Acquired with a Remidio smartphone fundus camera:
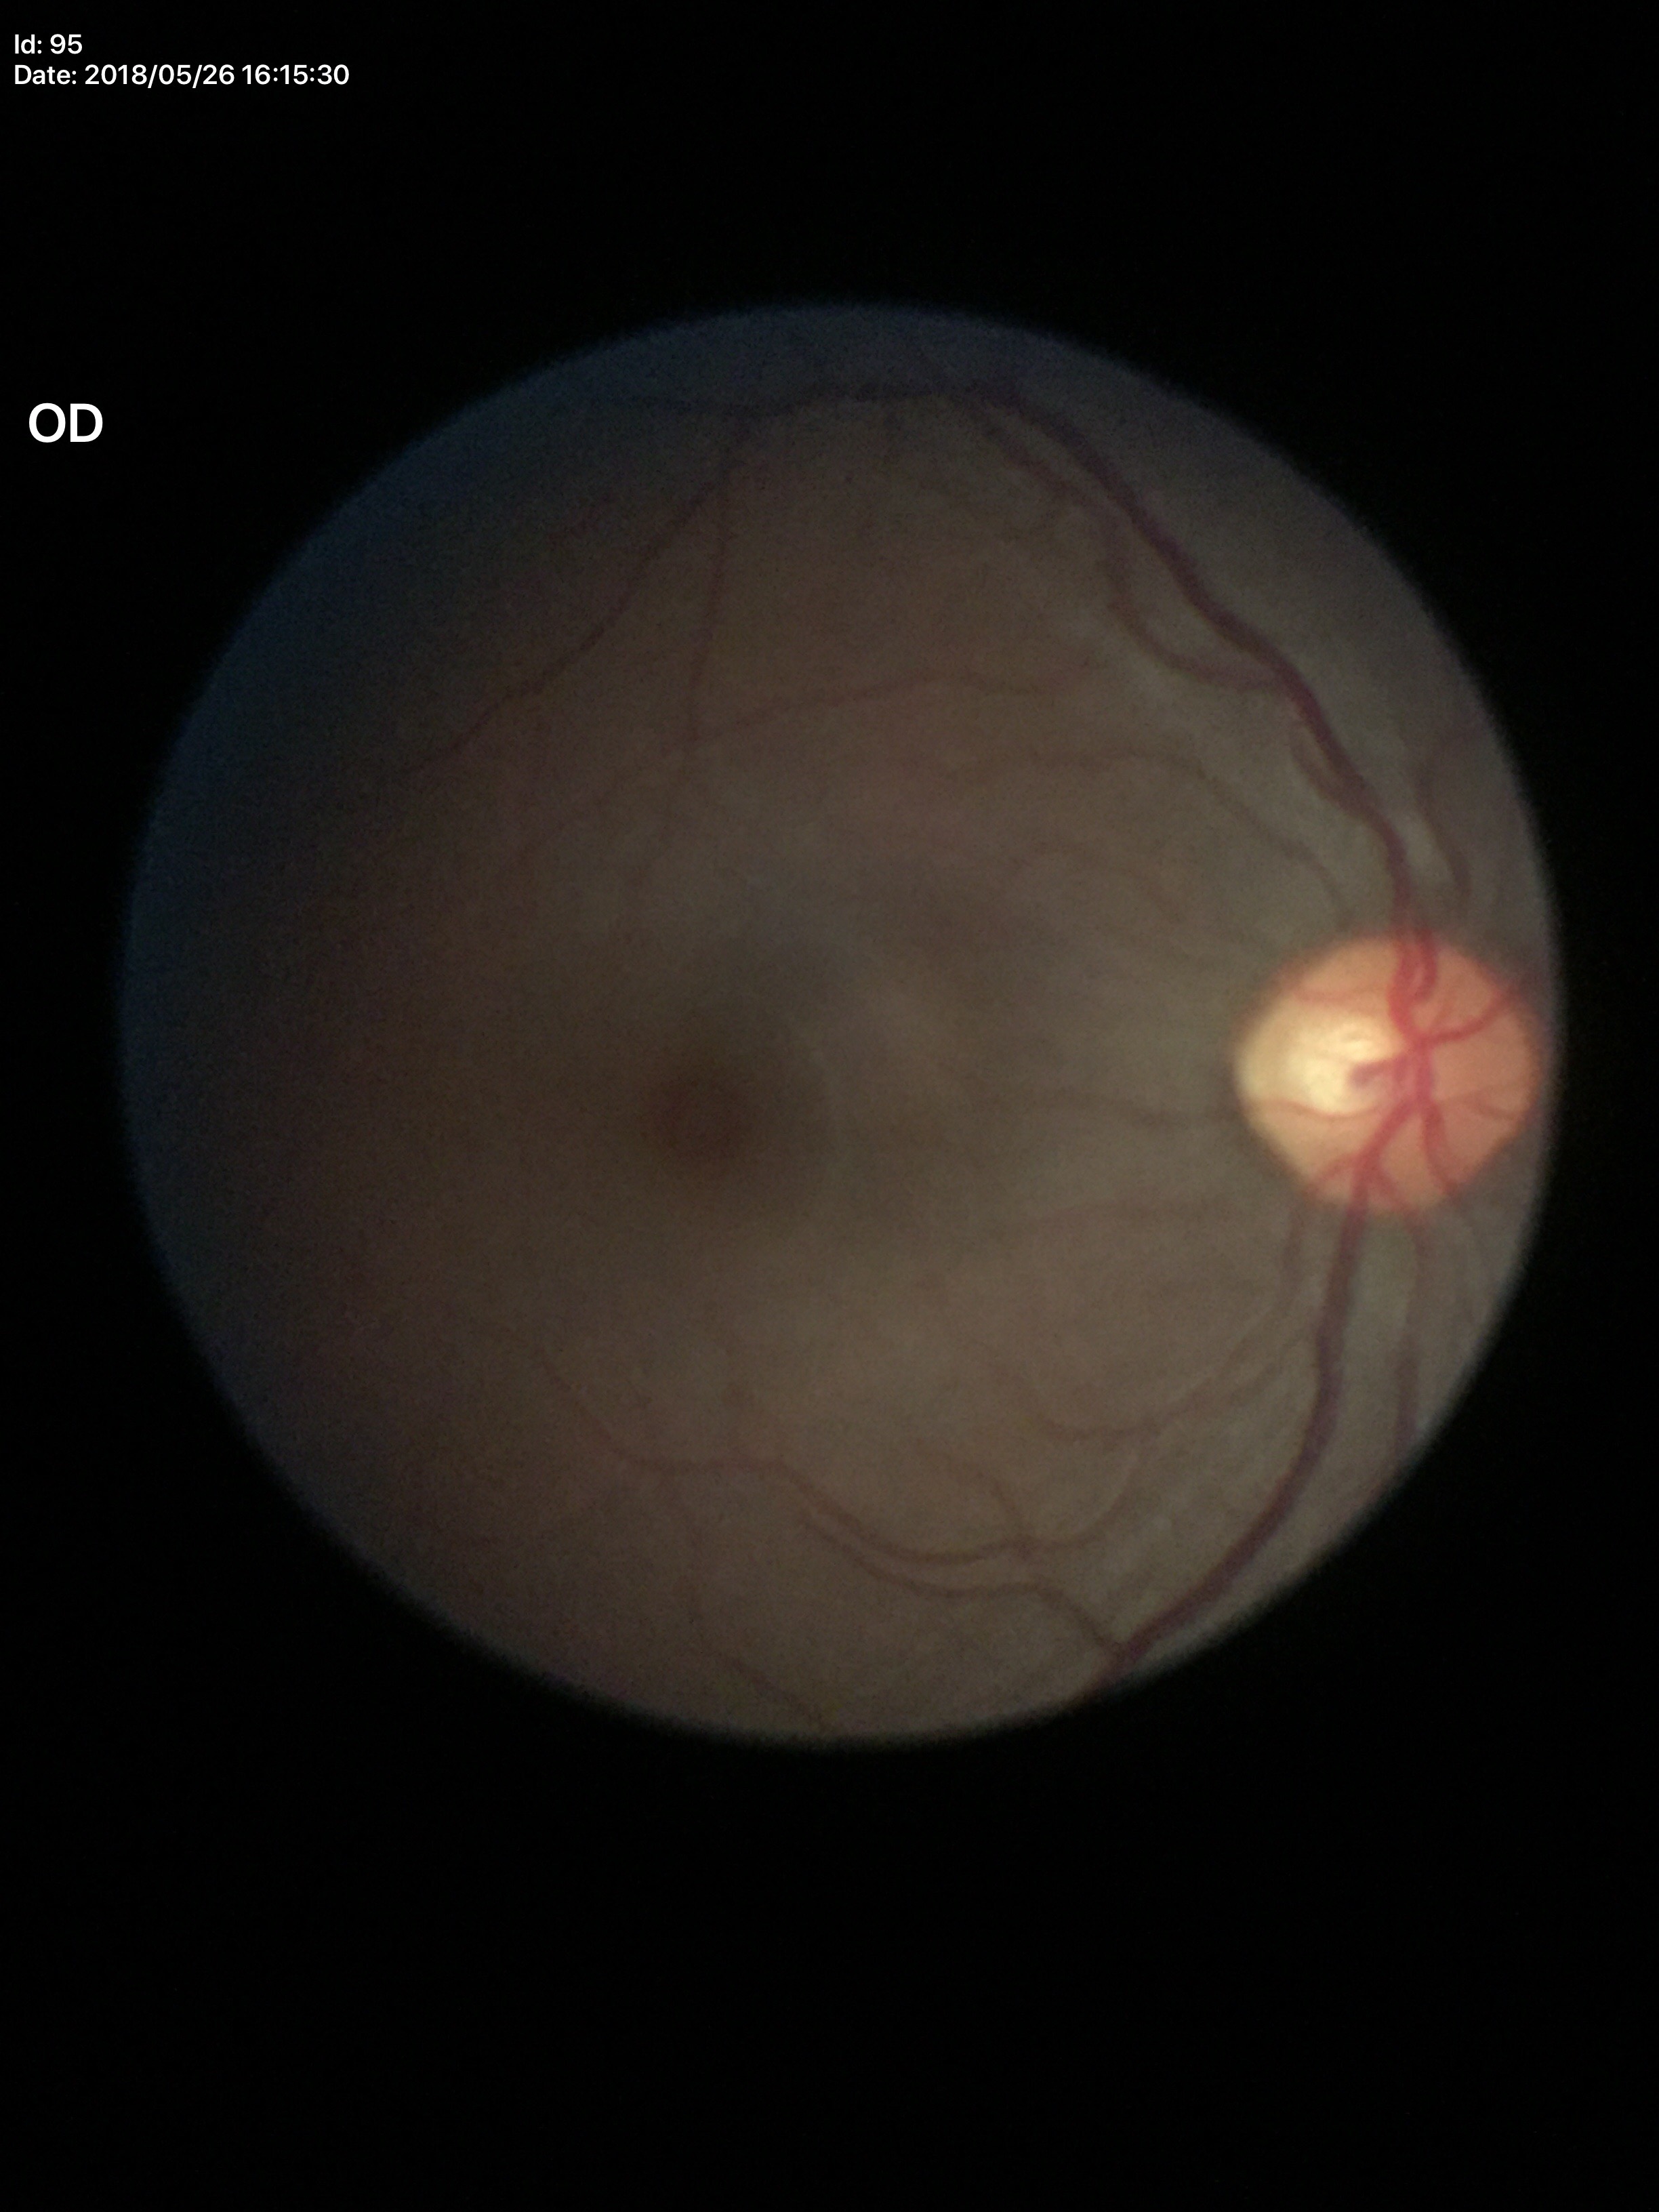 Findings:
- Glaucoma evaluation: not suspect
- VCDR: 0.52
- HCDR: 0.54